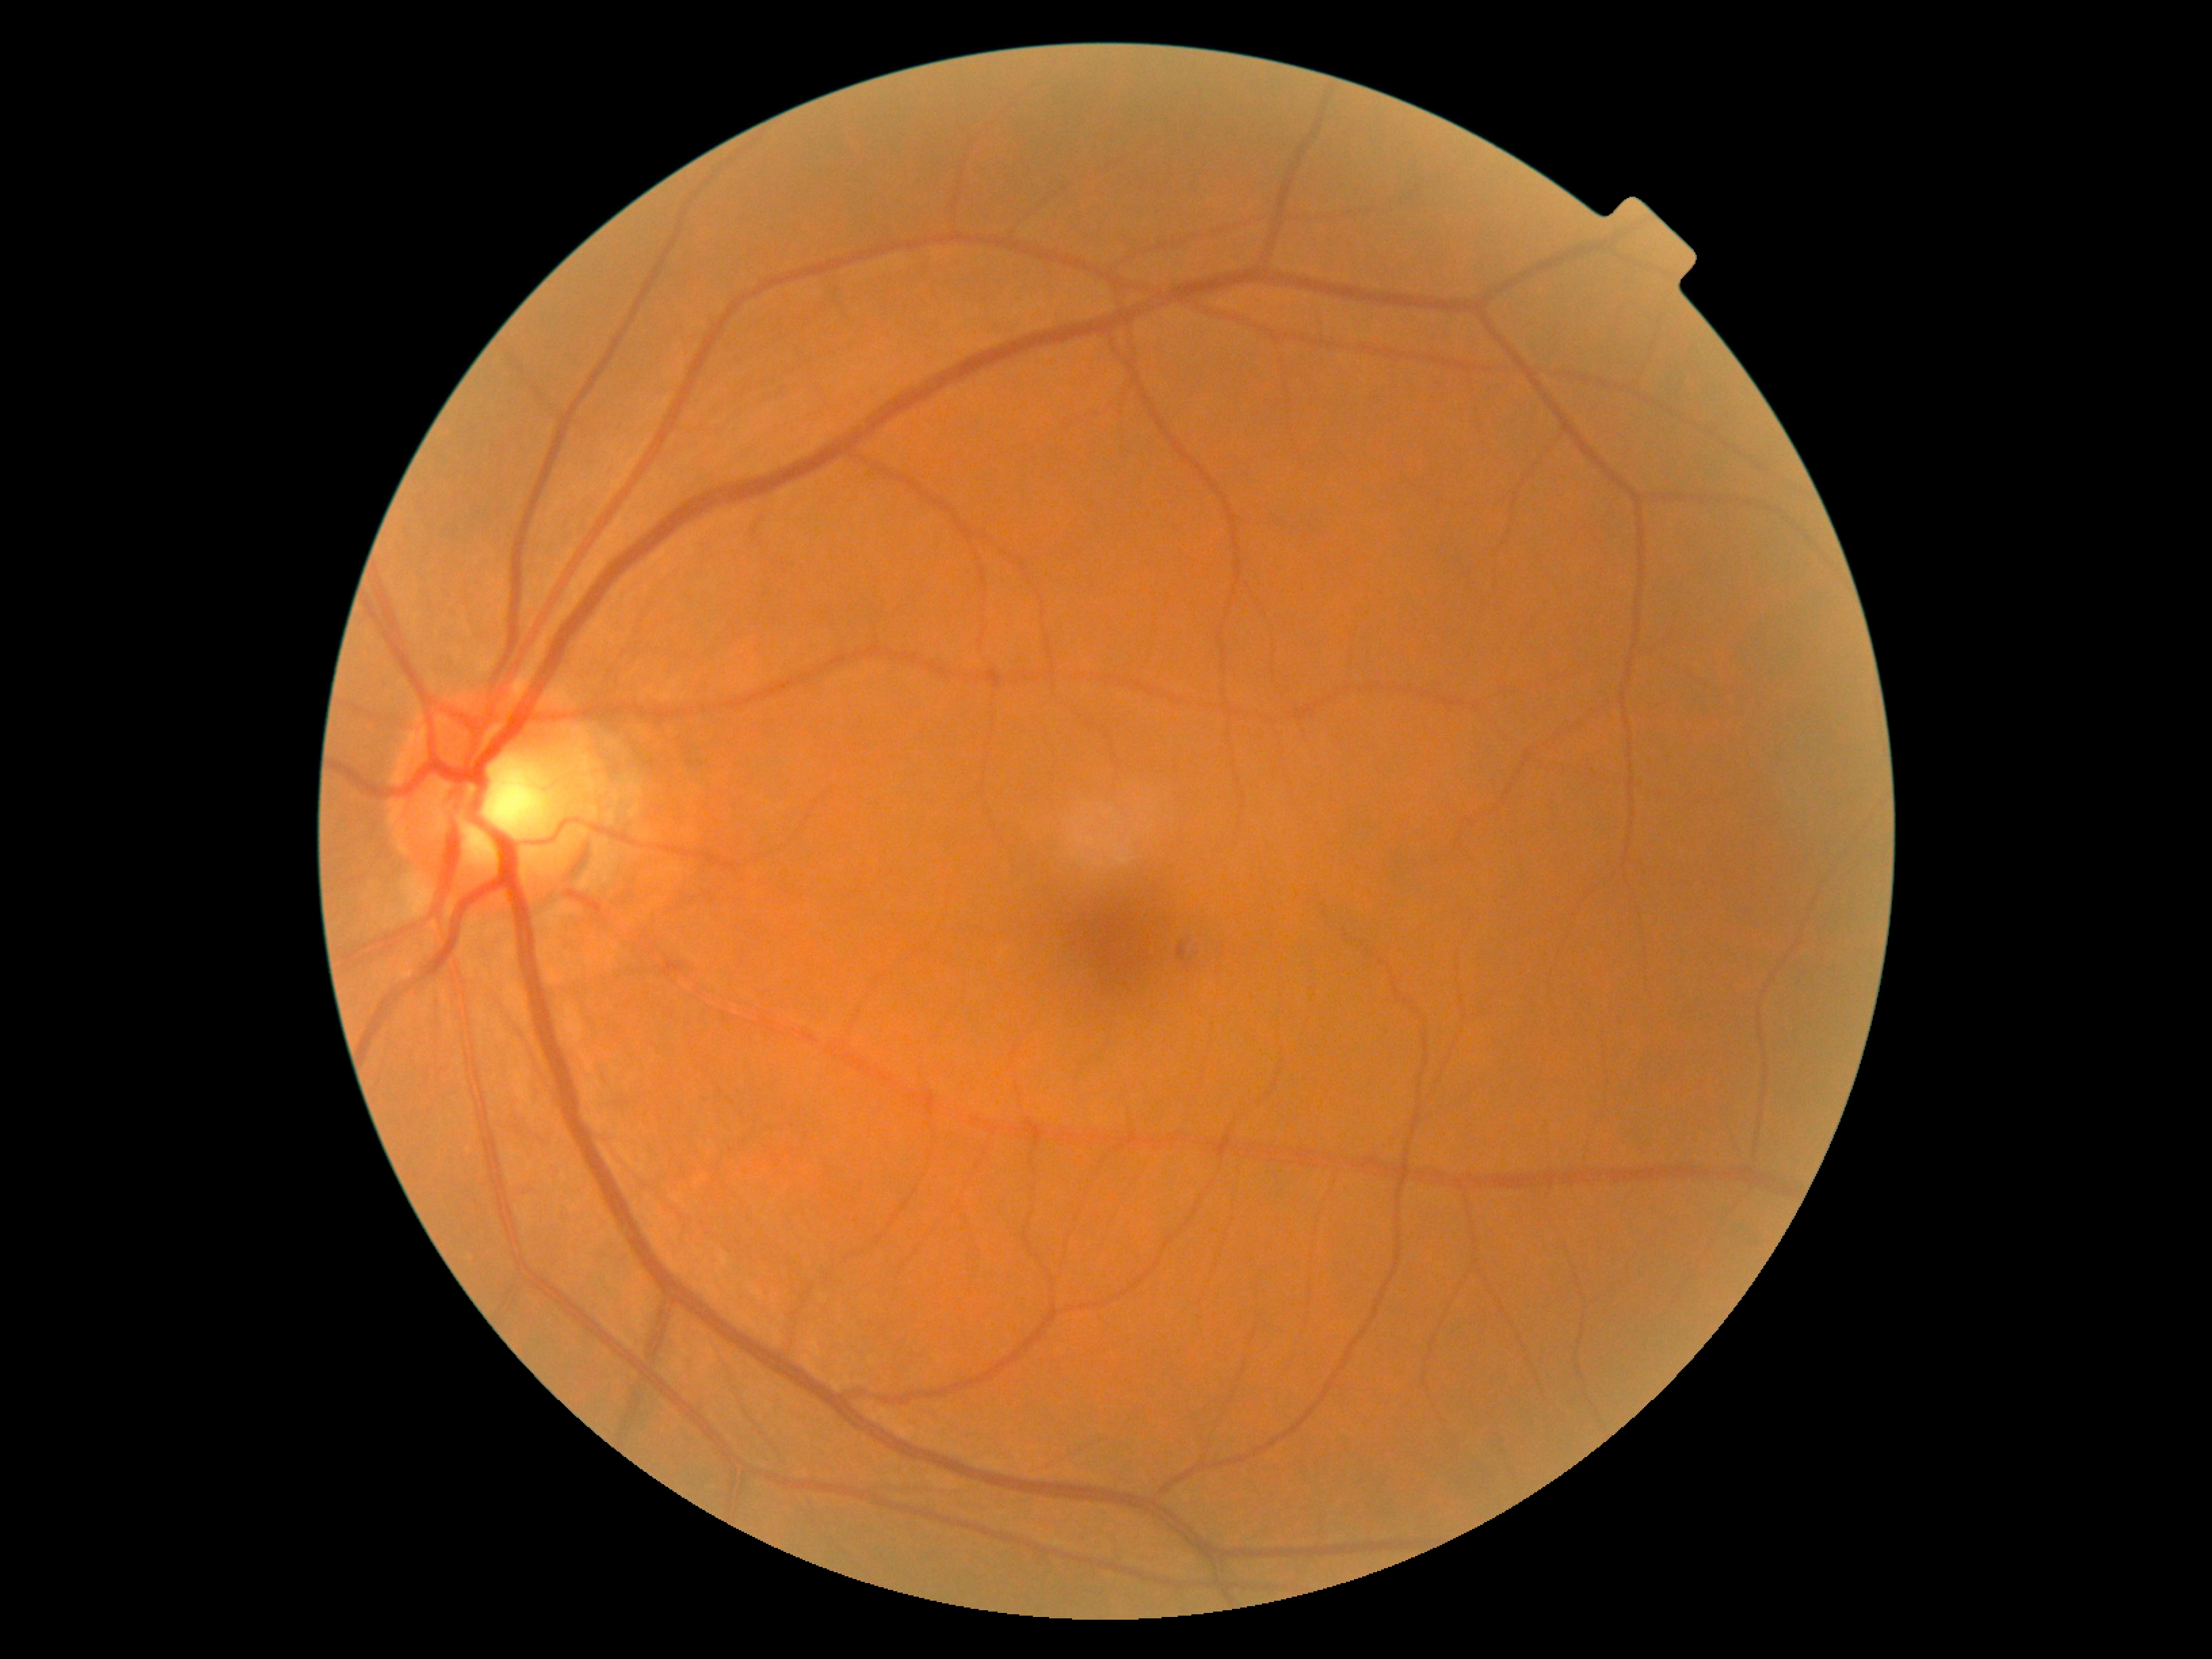

diabetic retinopathy (DR) = mild non-proliferative diabetic retinopathy (grade 1).